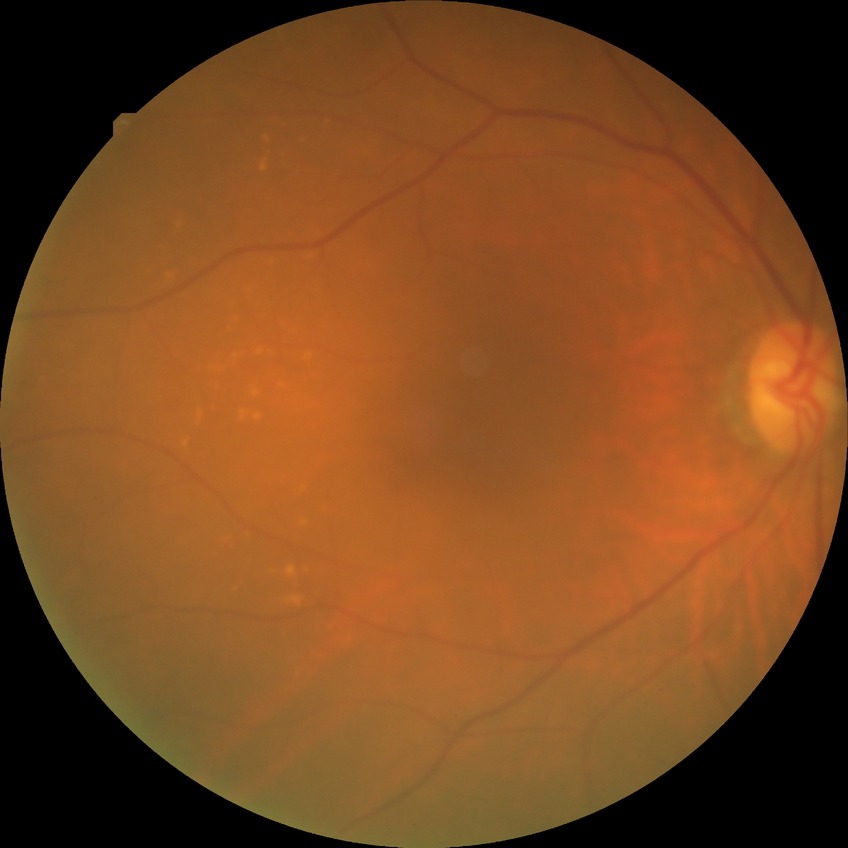

diabetic retinopathy (DR) = no diabetic retinopathy (NDR)